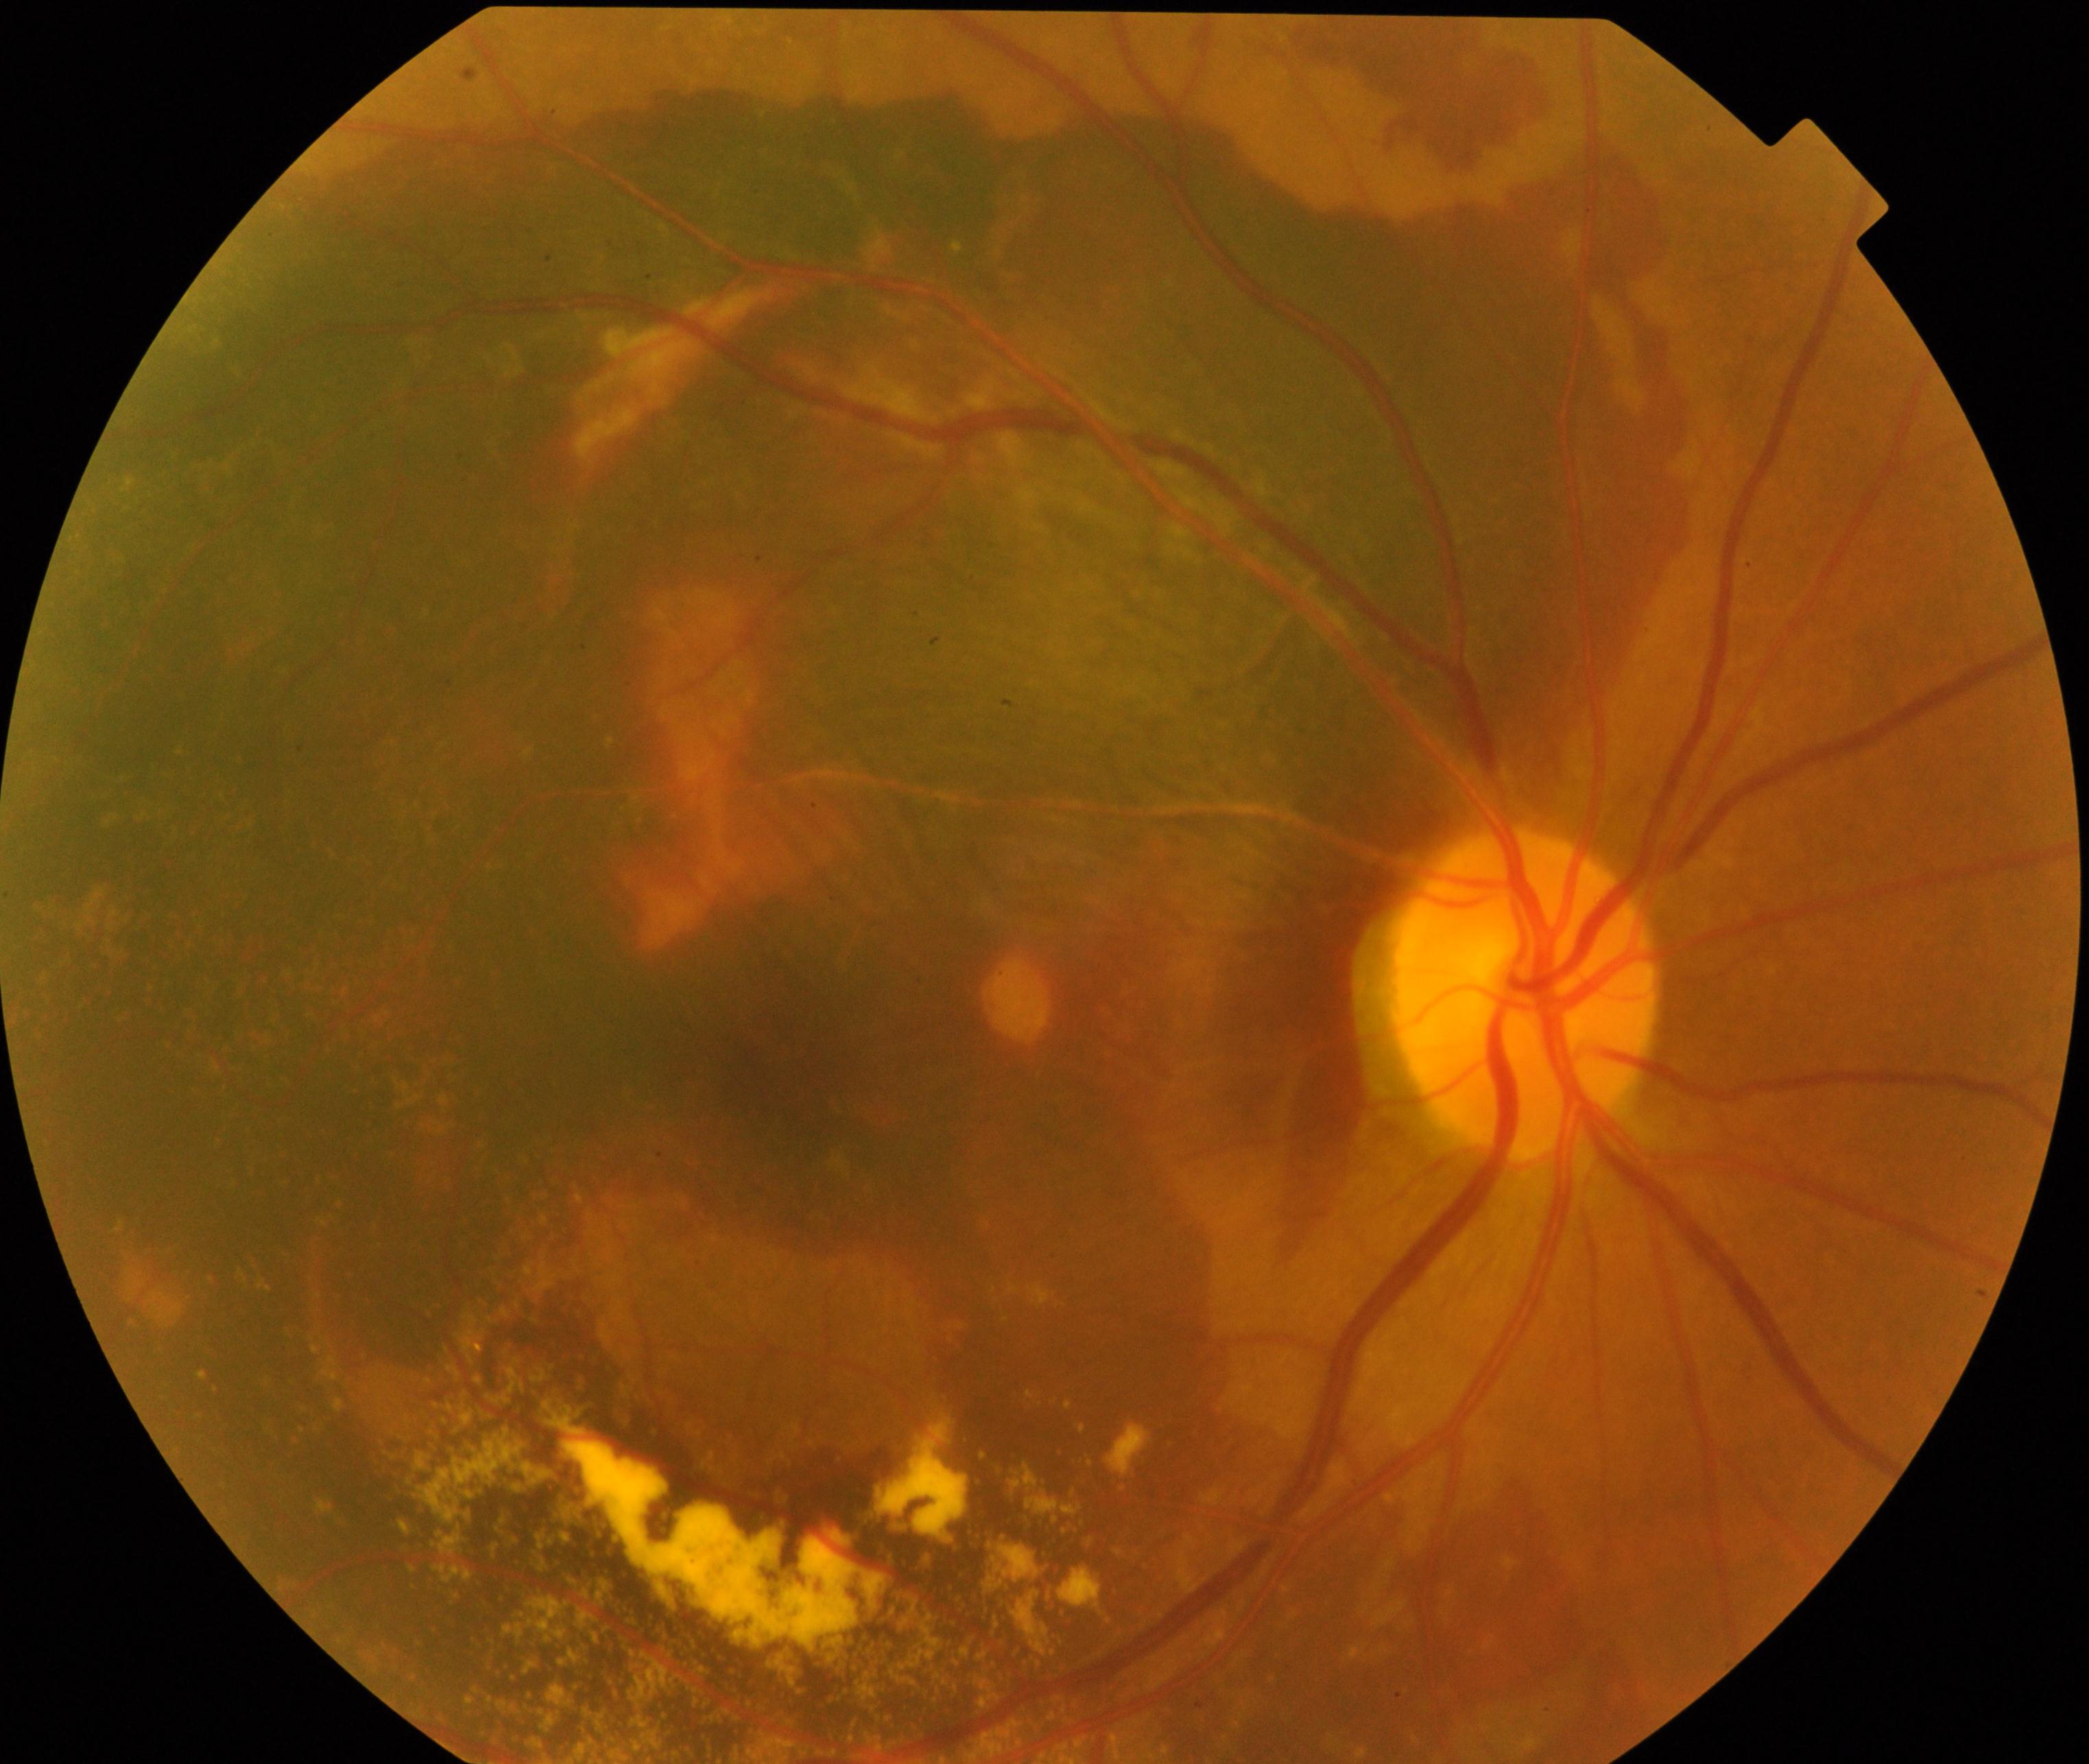

Findings: maculopathy.